Wide-field fundus image from infant ROP screening; camera: Clarity RetCam 3 (130° FOV); image size 640x480 — 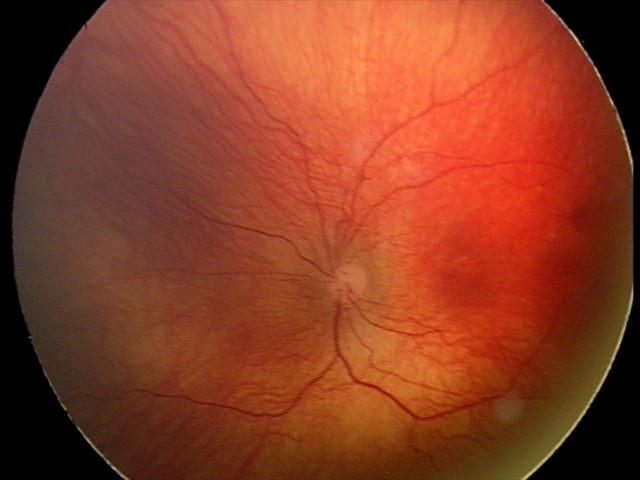

Screening series with status post retinopathy of prematurity — retinal appearance after treated retinopathy of prematurity.